200° field of view · ultra-widefield fundus photograph: 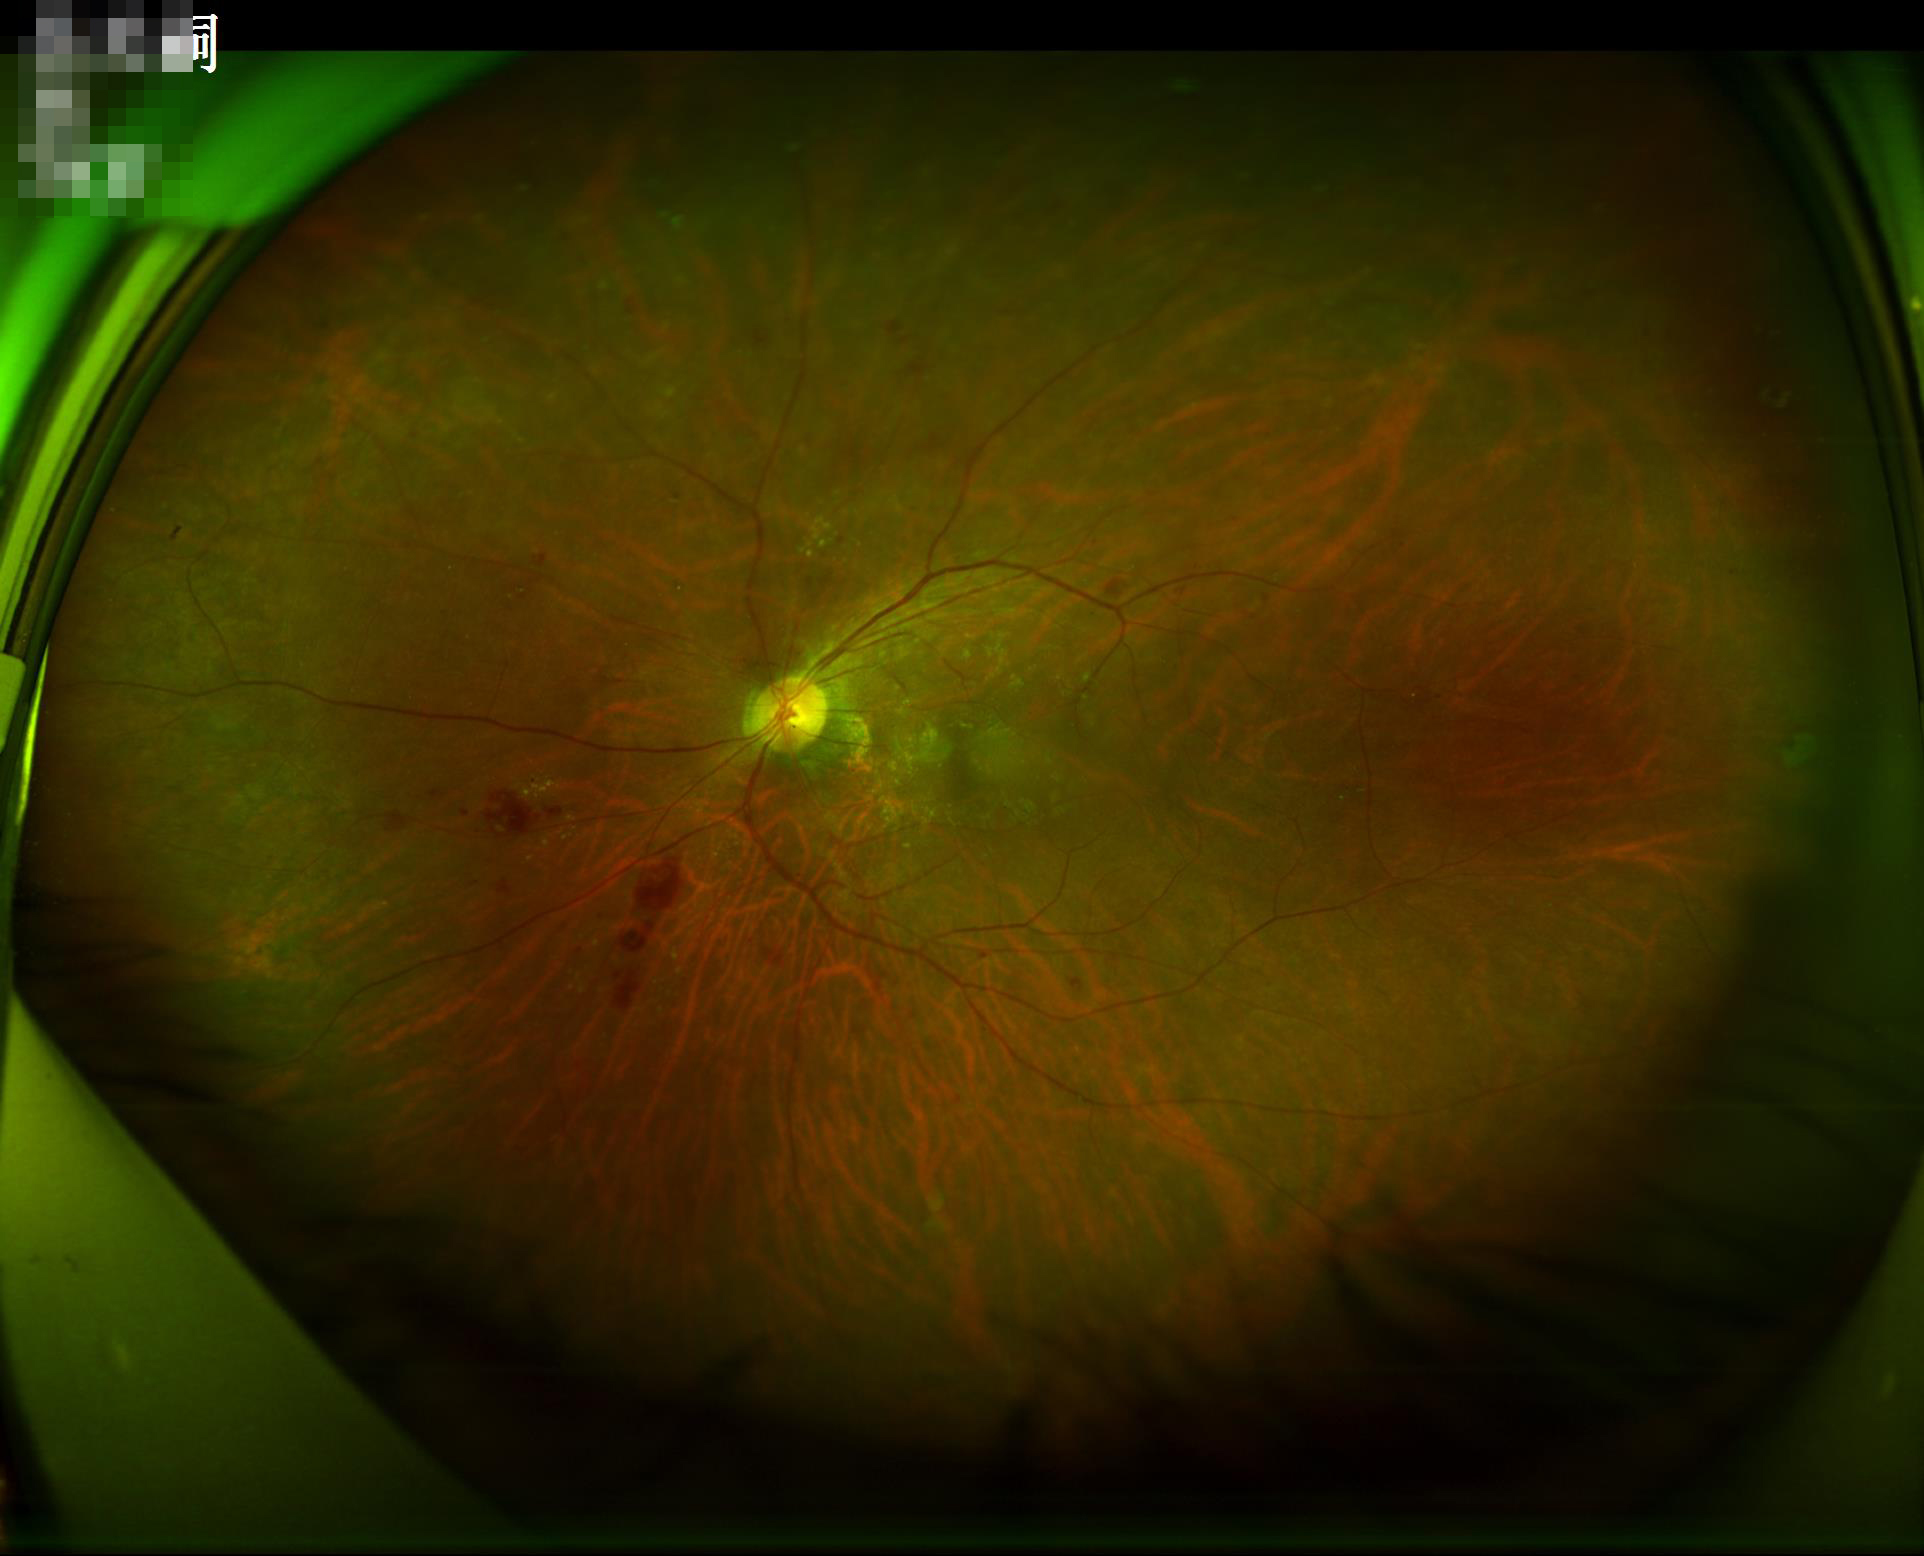
Vessels and details are readily distinguishable.
The image is clear.
Even illumination with no color cast.
Overall image quality is good.